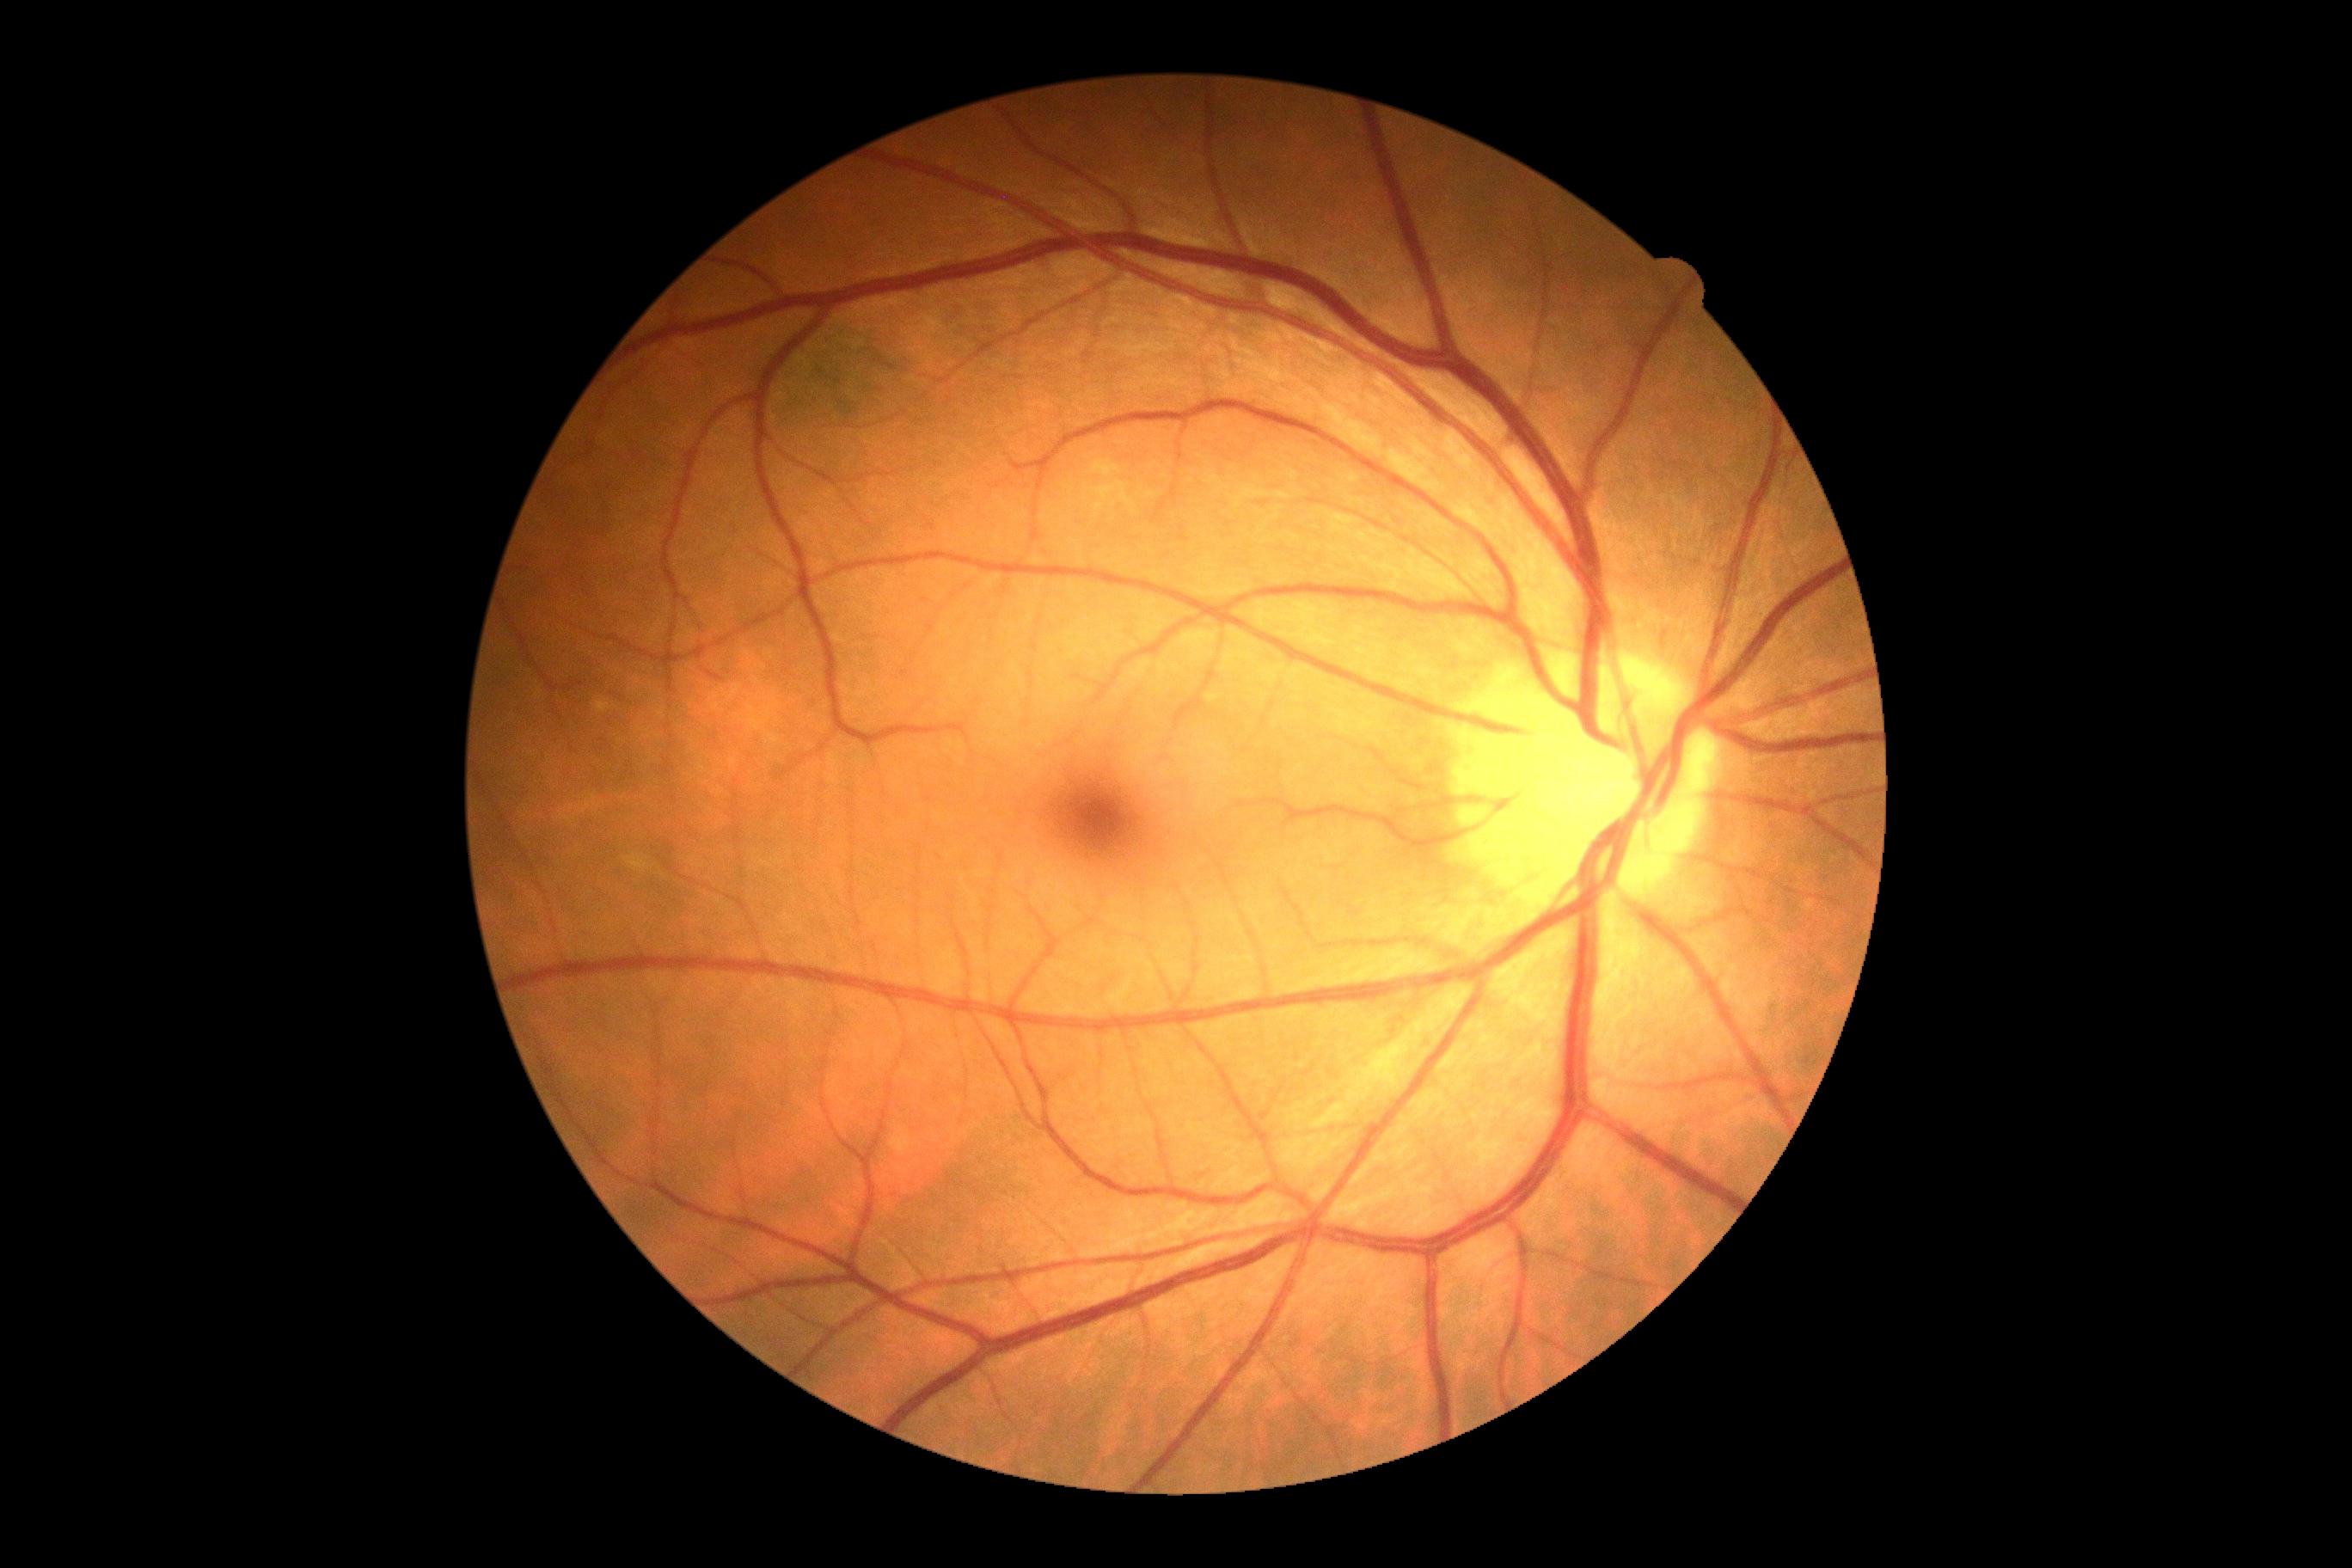

{"dr_grade": "0 — no visible signs of diabetic retinopathy"}